Davis DR grading — 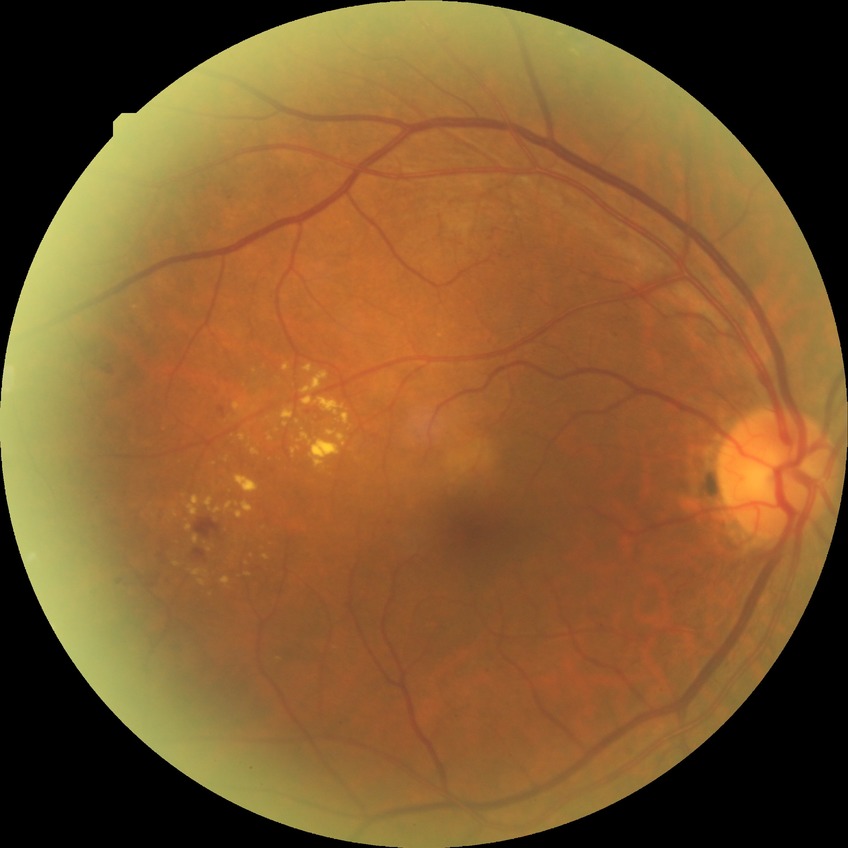

modified Davis grade: SDR.